Wide-field fundus photograph of an infant
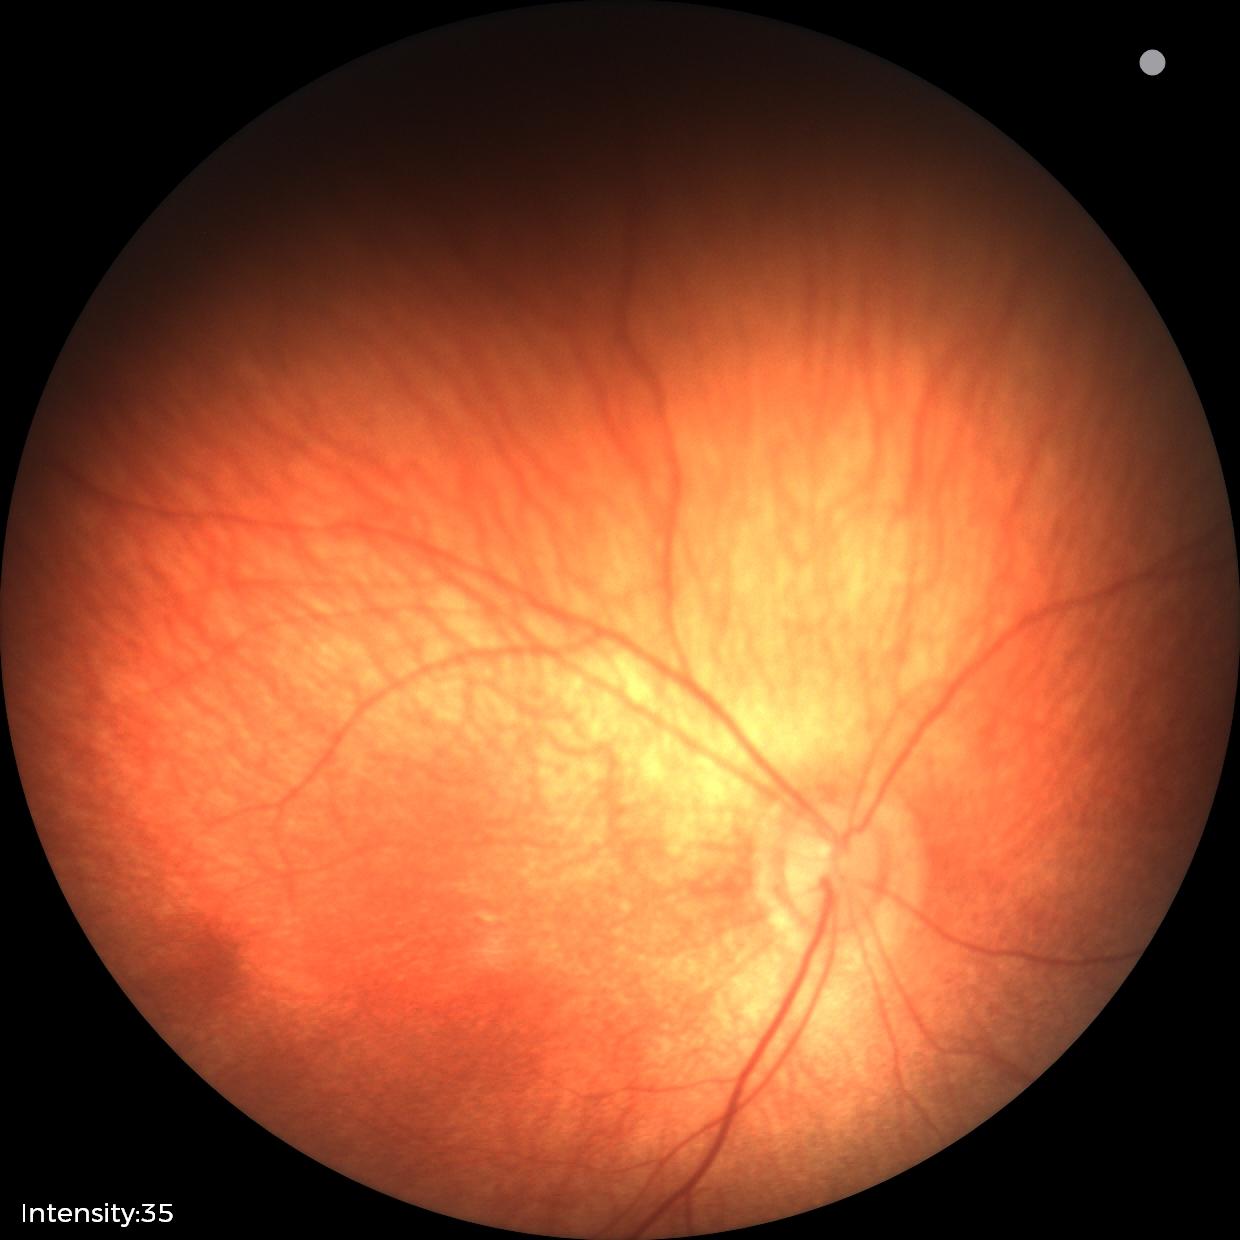
Physiological retinal appearance for postconceptual age.